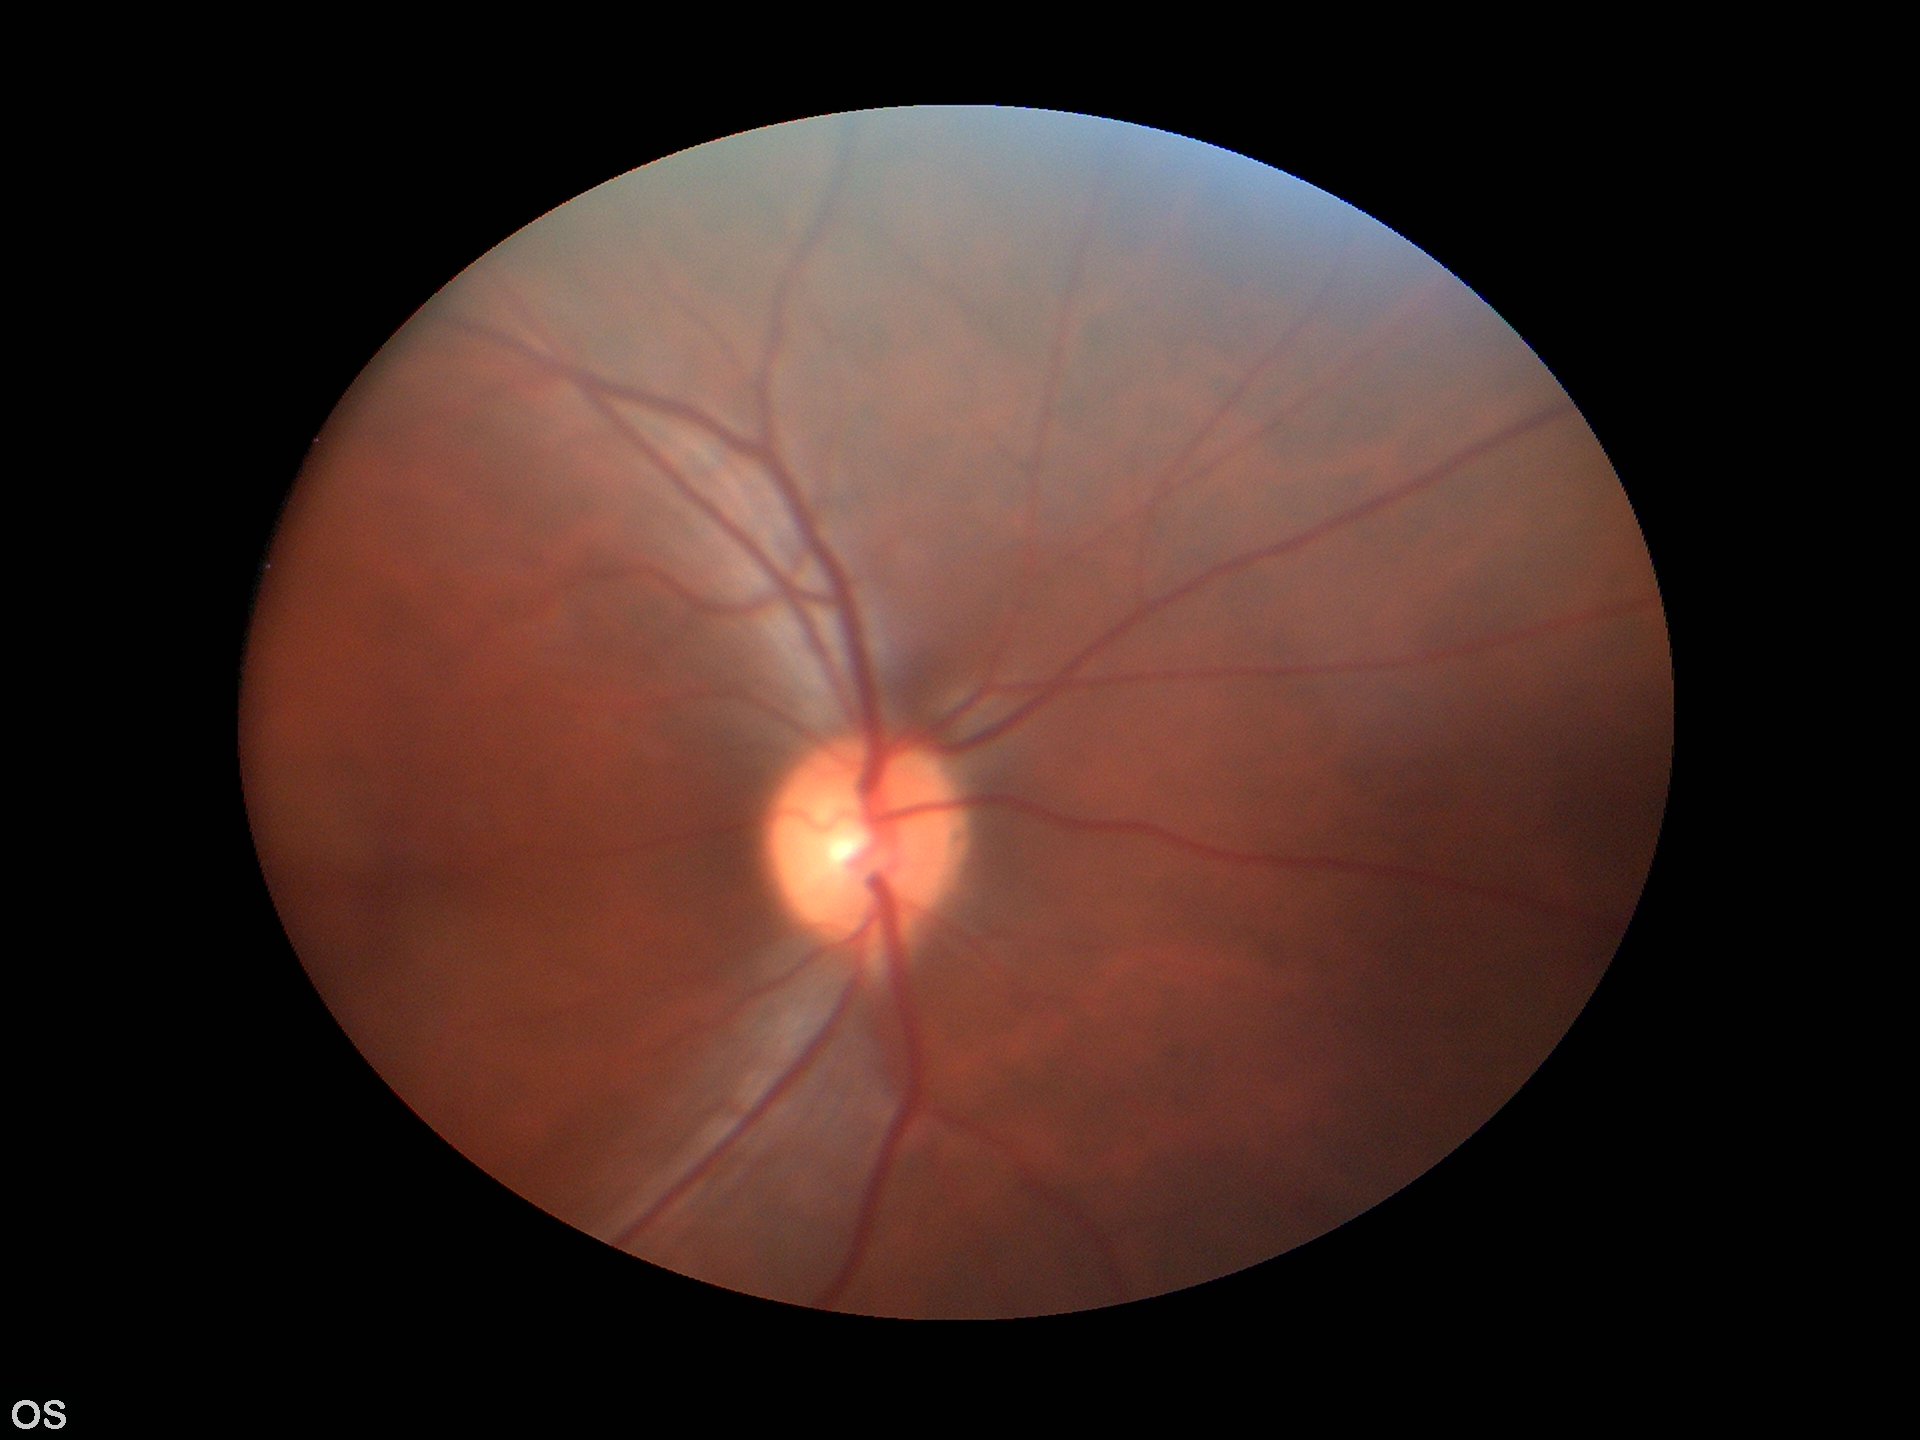
VCDR is 0.47.
HCDR: 0.47.
No evidence of glaucoma (all 5 graders called normal).